45° FOV:
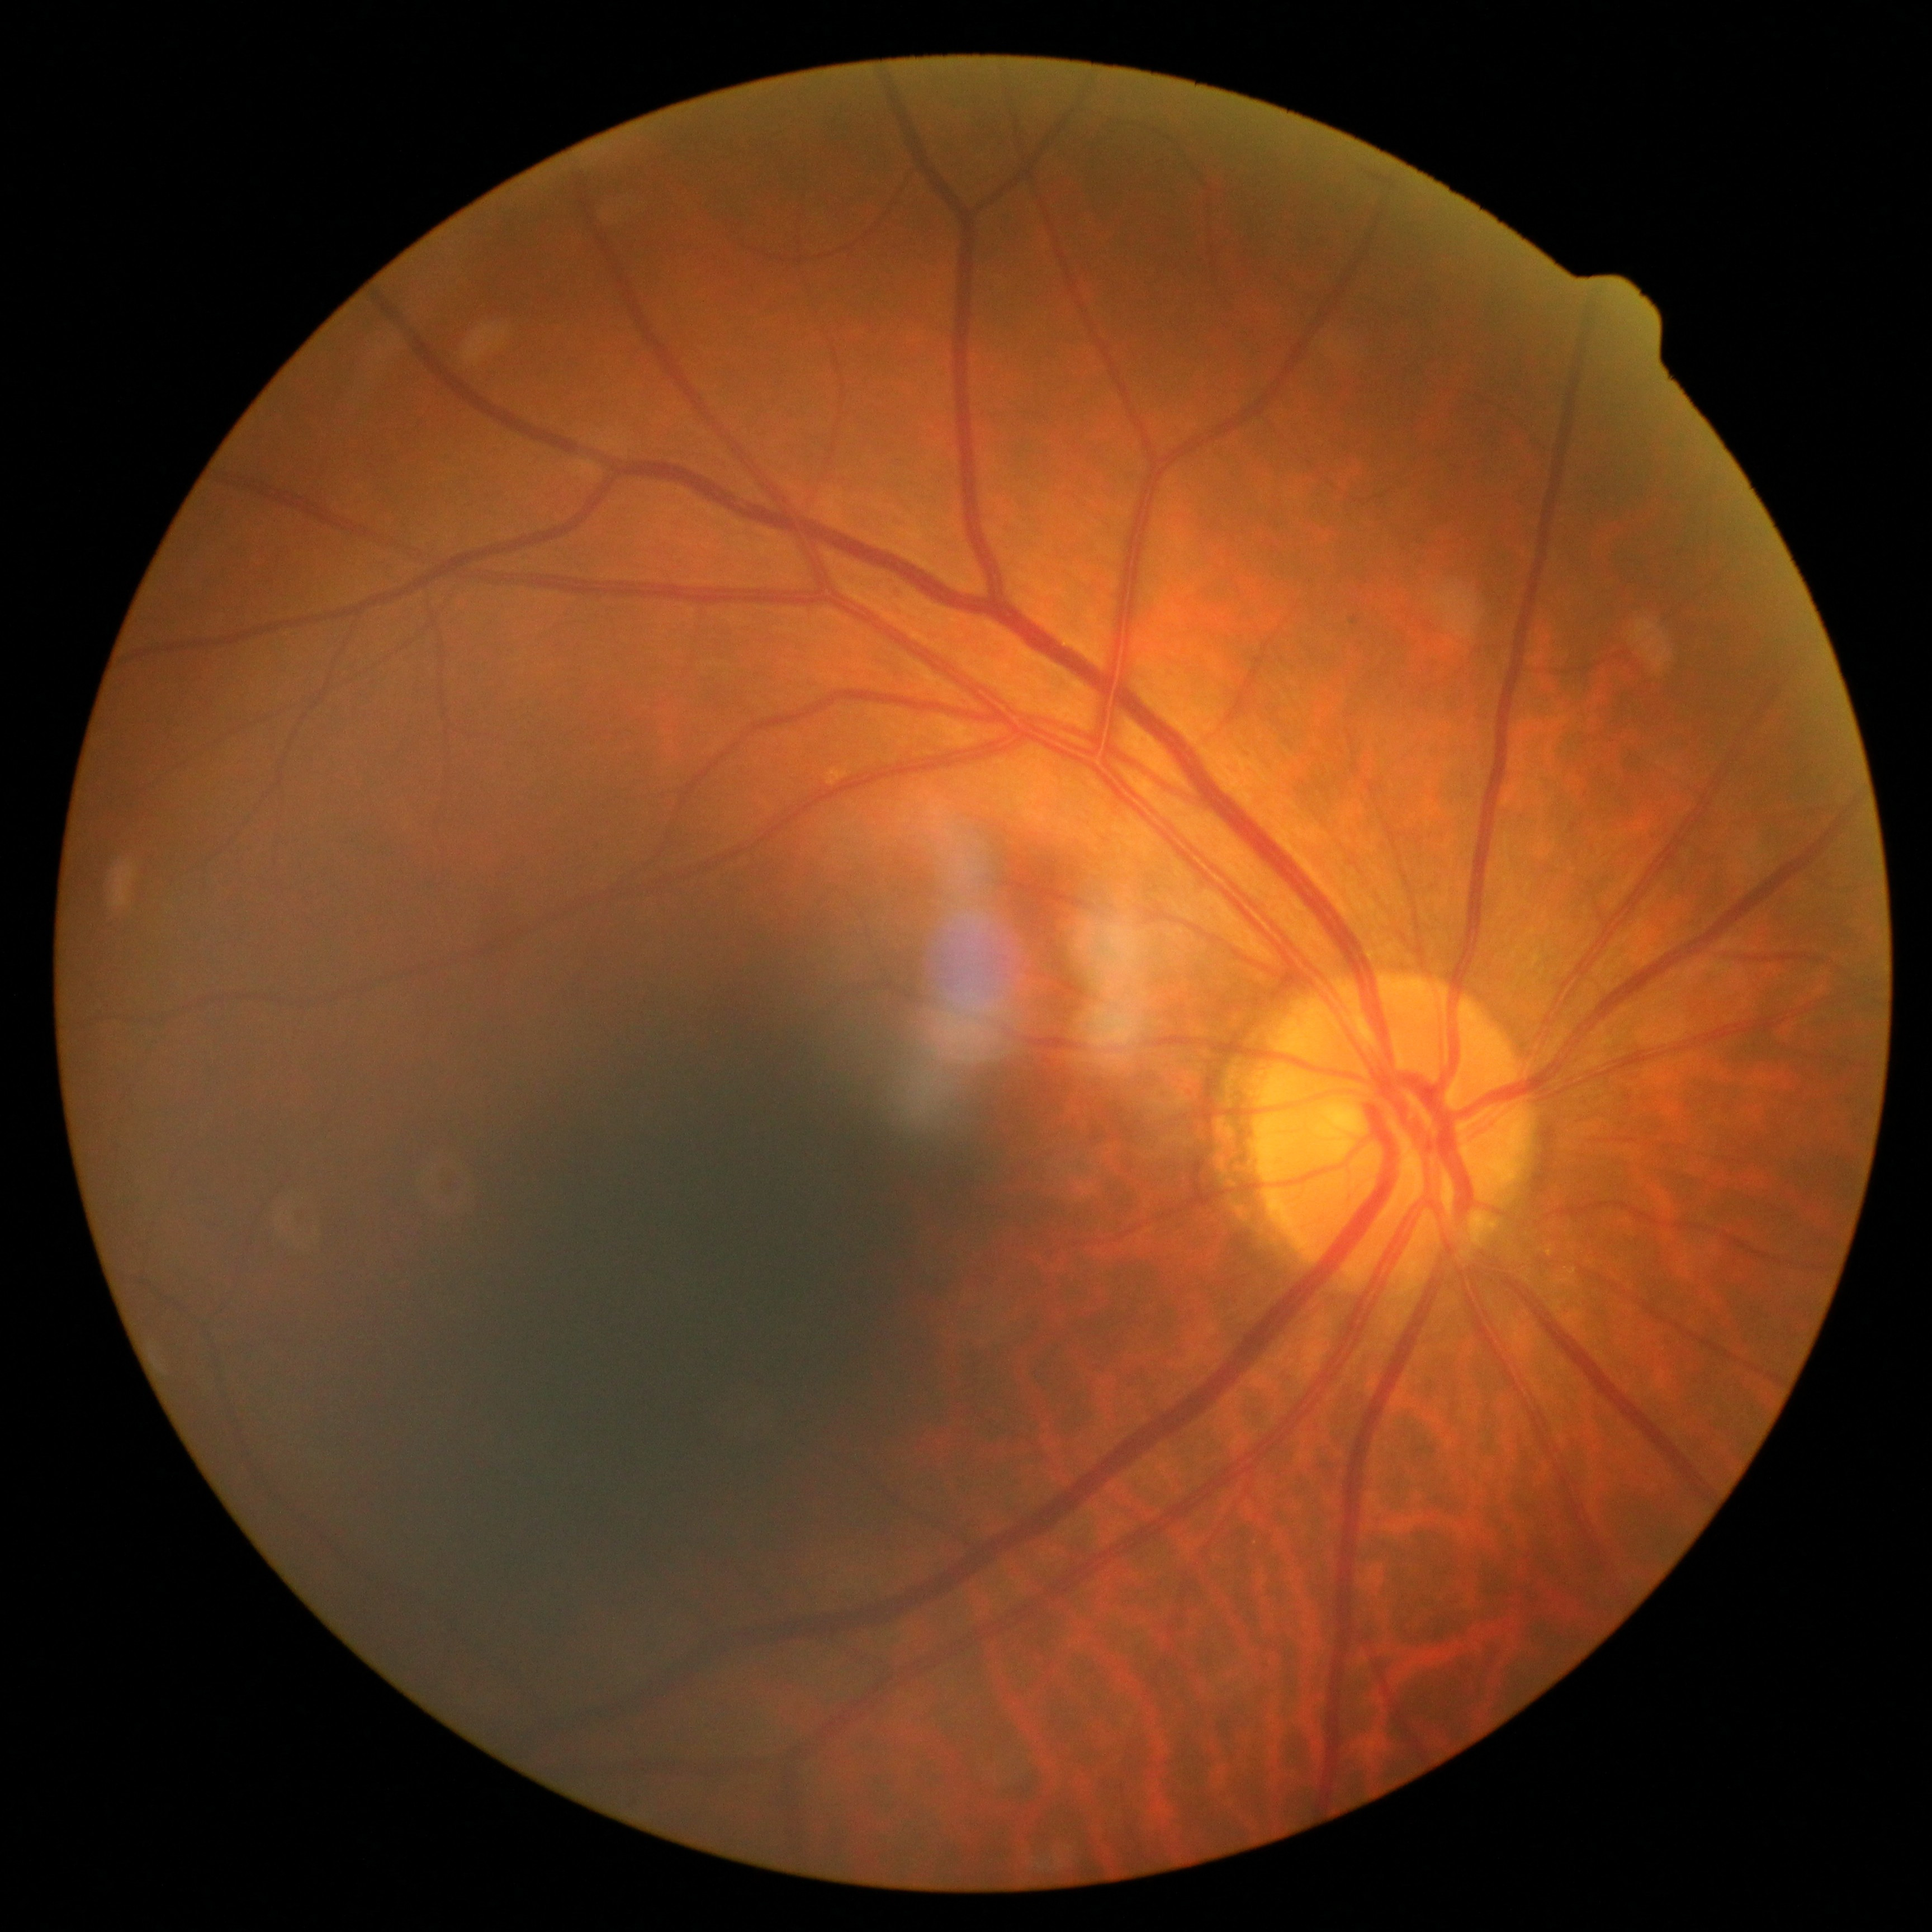

Diabetic retinopathy grade: 0 (no apparent retinopathy) — no visible signs of diabetic retinopathy.